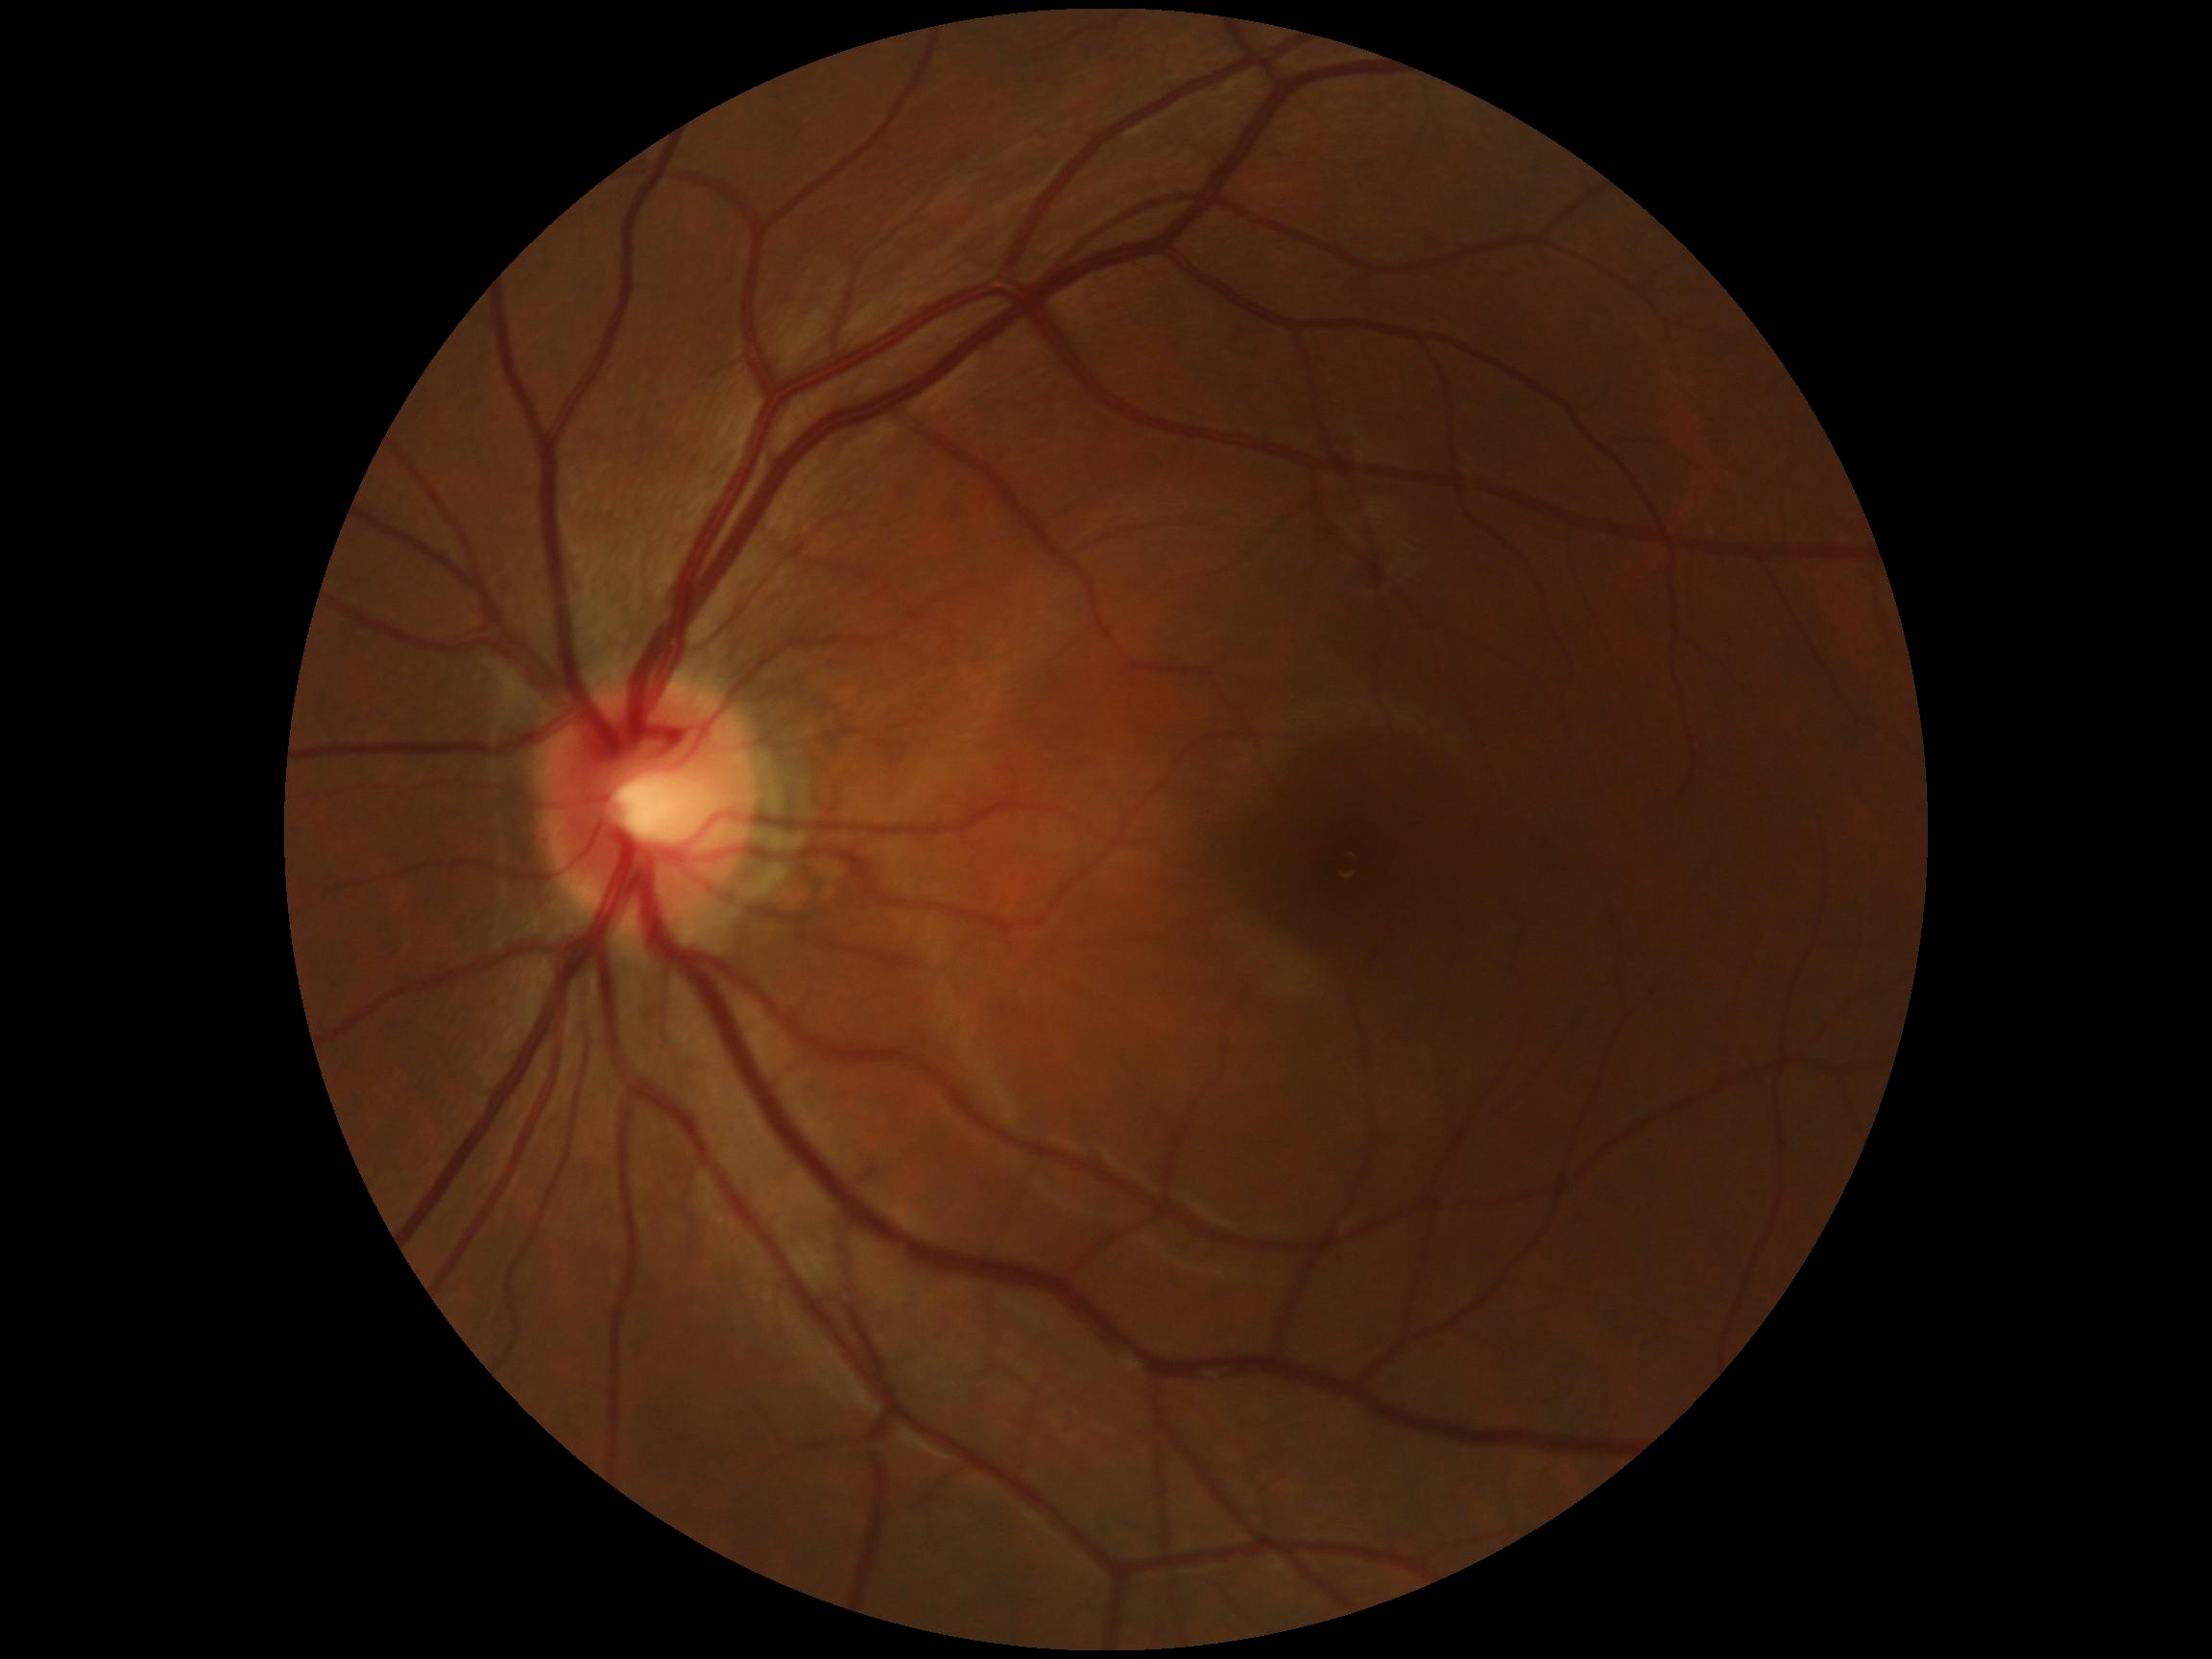 Diabetic retinopathy (DR): no apparent retinopathy (grade 0).